848 x 848 pixels:
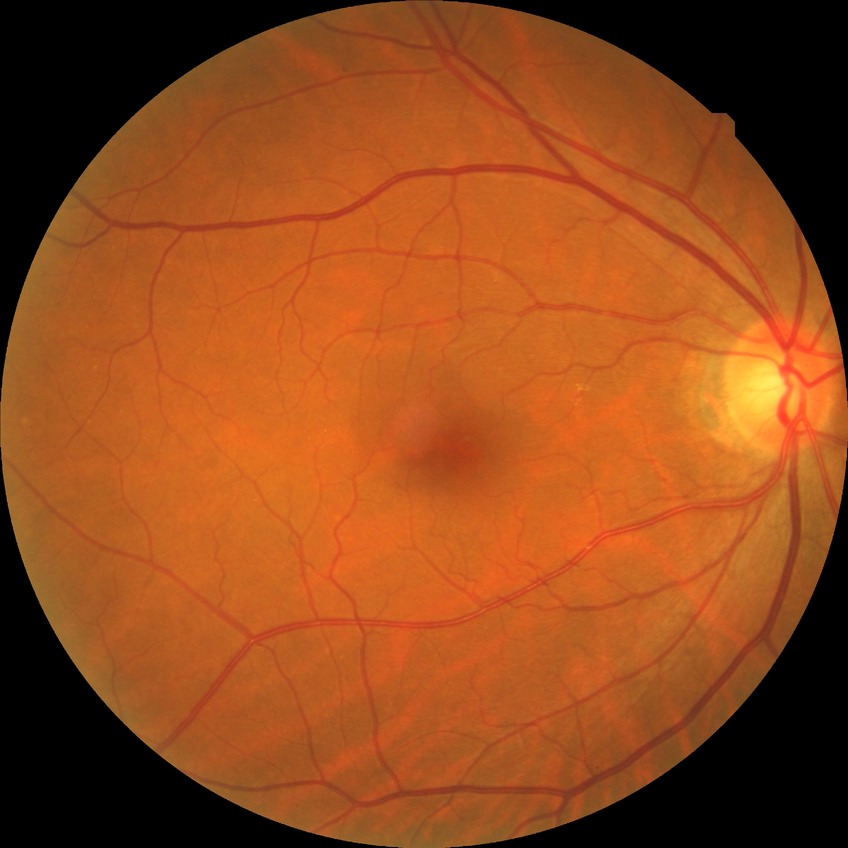

Diabetic retinopathy grade: no diabetic retinopathy.